1659x2212px; acquired with a Remidio FOP fundus camera; retinal fundus photograph
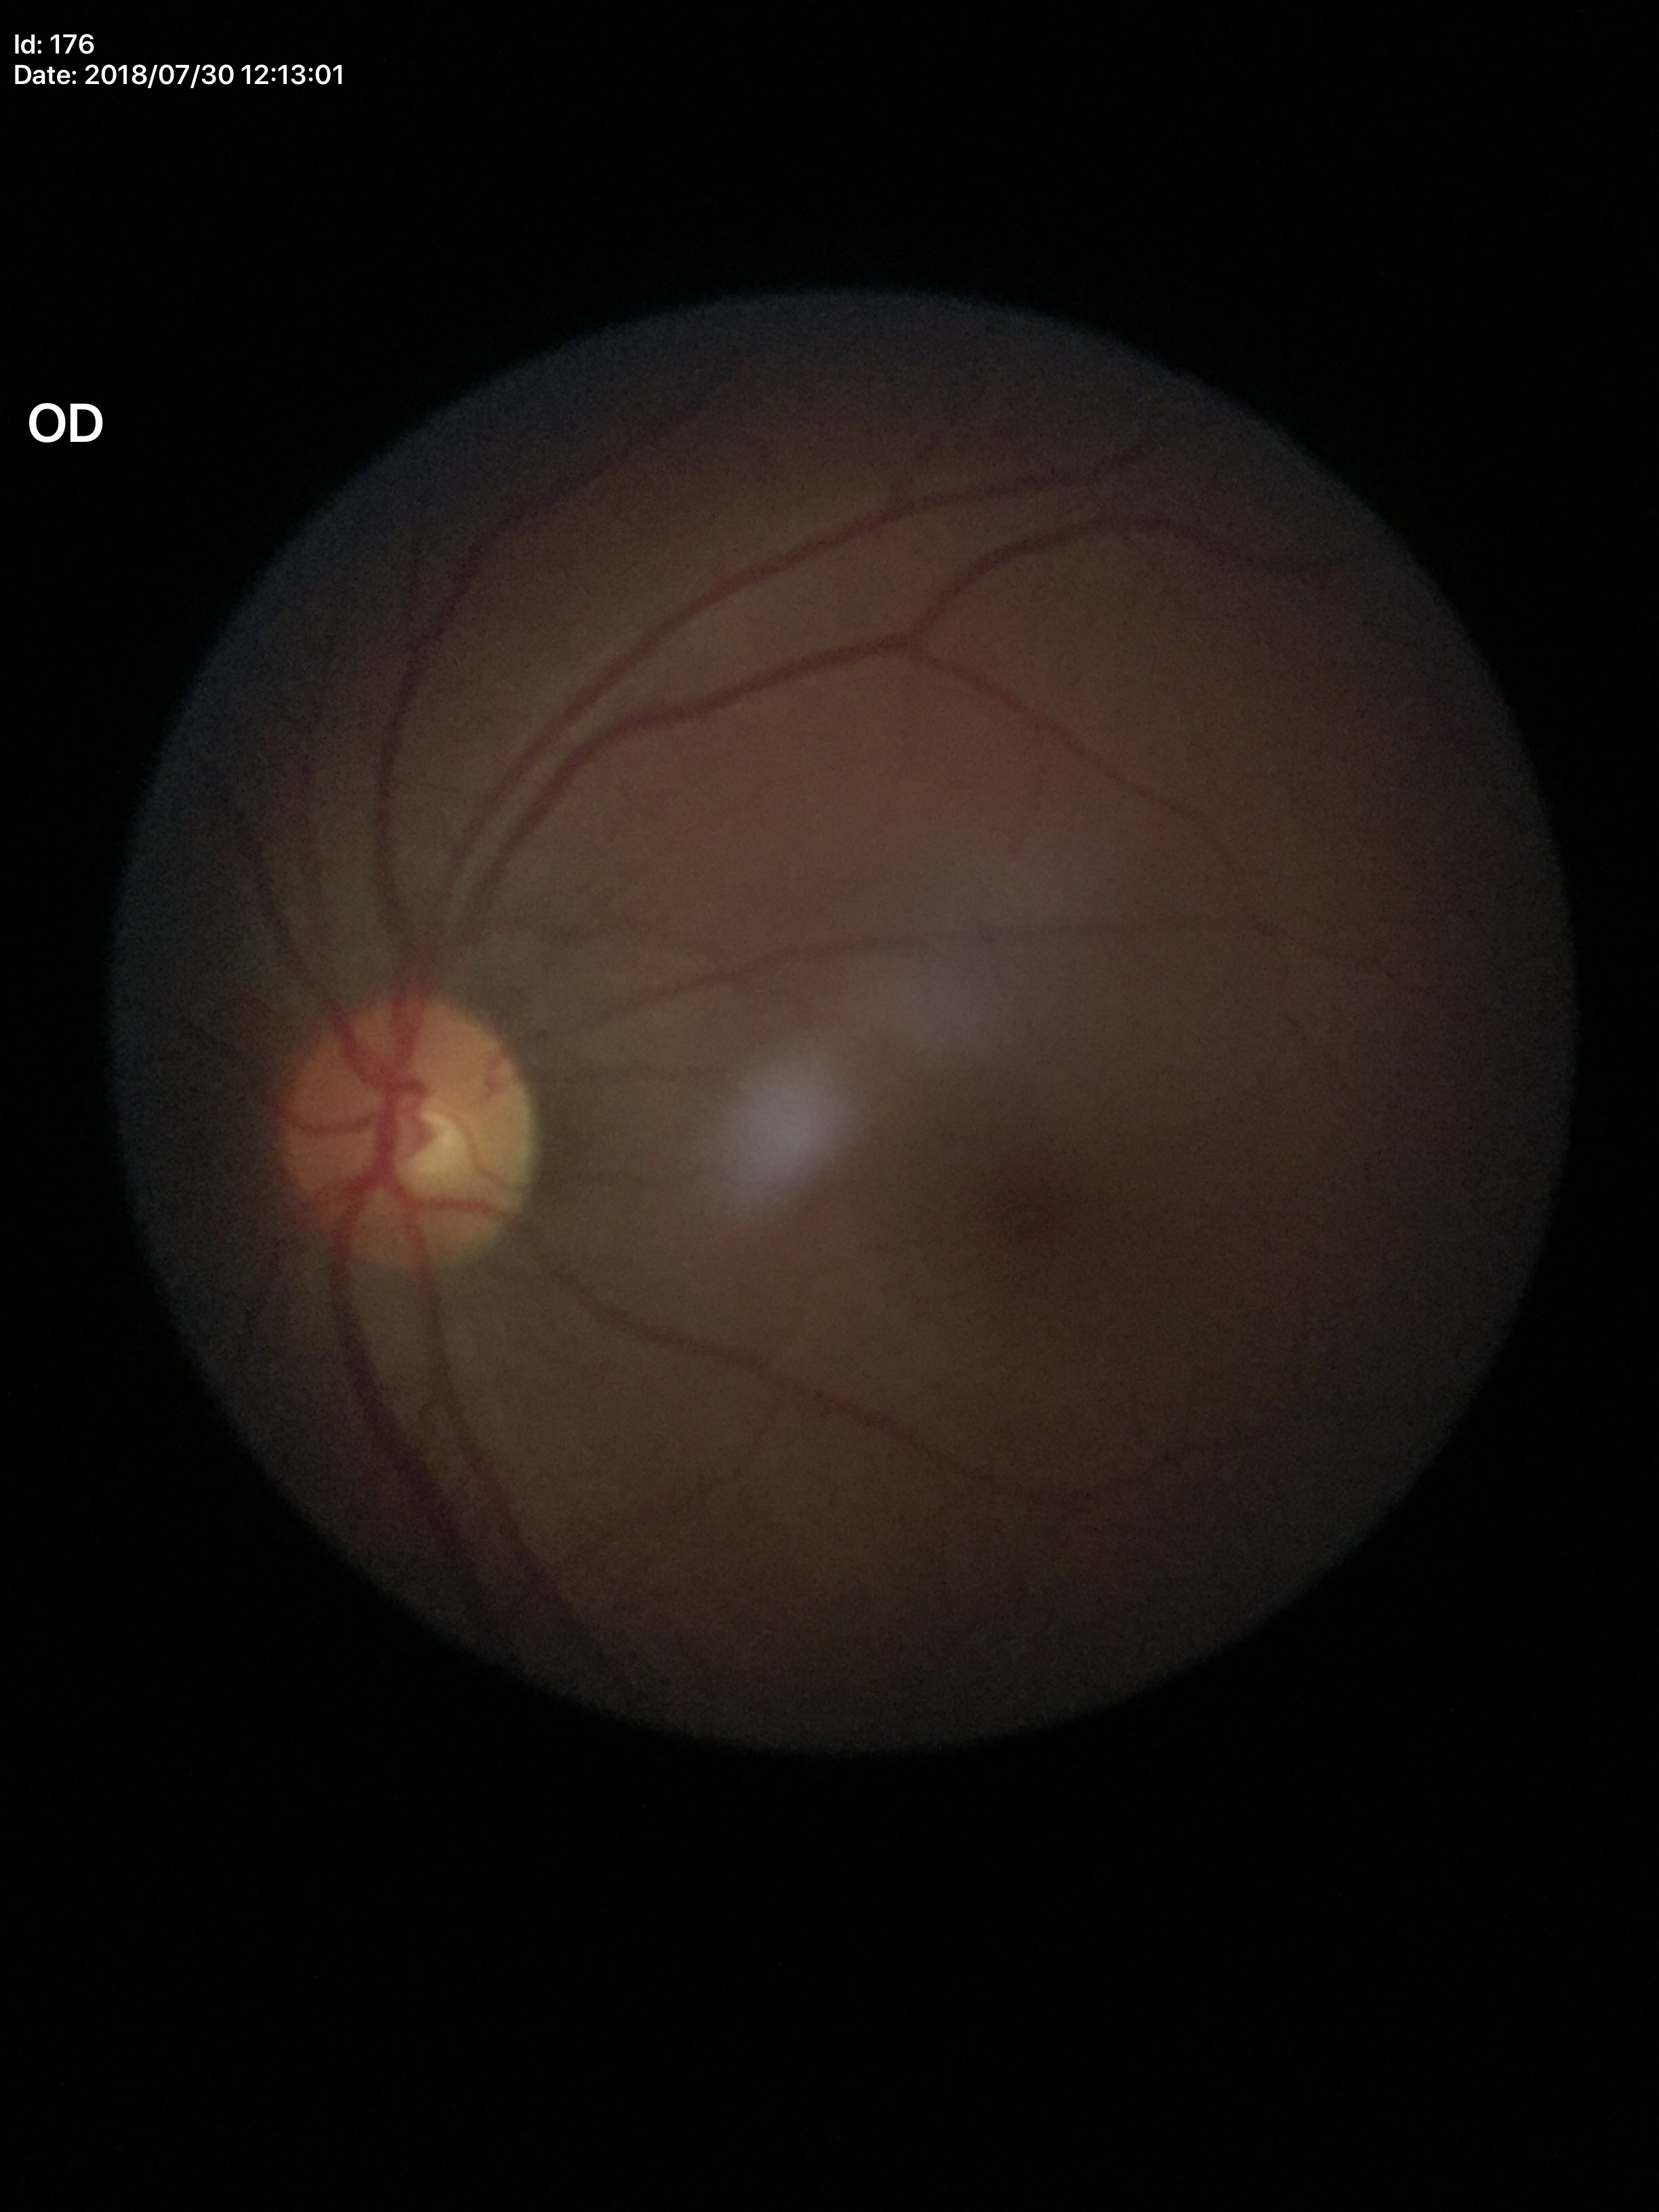 Glaucoma evaluation: no suspicious findings | vertical C/D ratio: 0.43